848x848px:
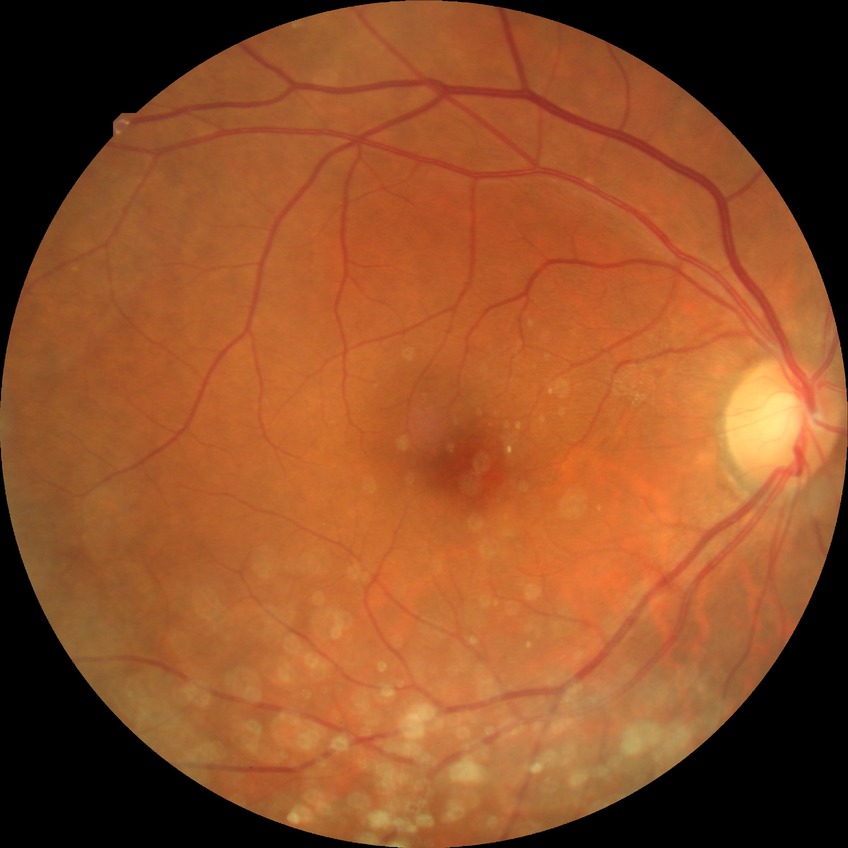

Retinopathy grade is no diabetic retinopathy.